Posterior pole color fundus photograph · 848 by 848 pixels:
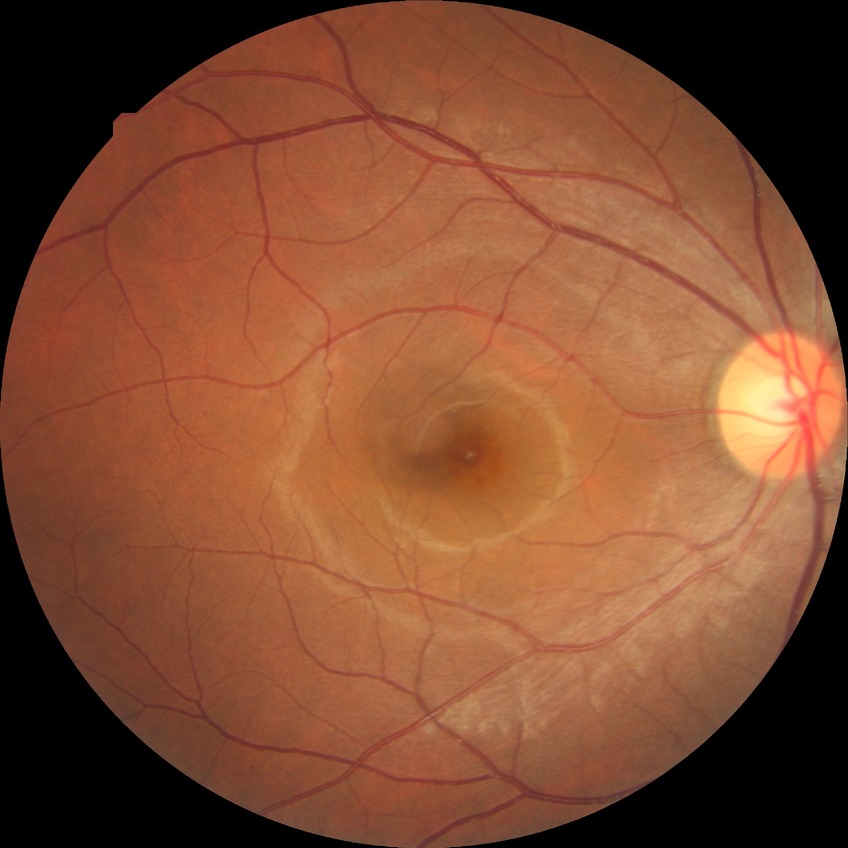 diabetic retinopathy (DR) = no diabetic retinopathy (NDR).